45 degree fundus photograph.
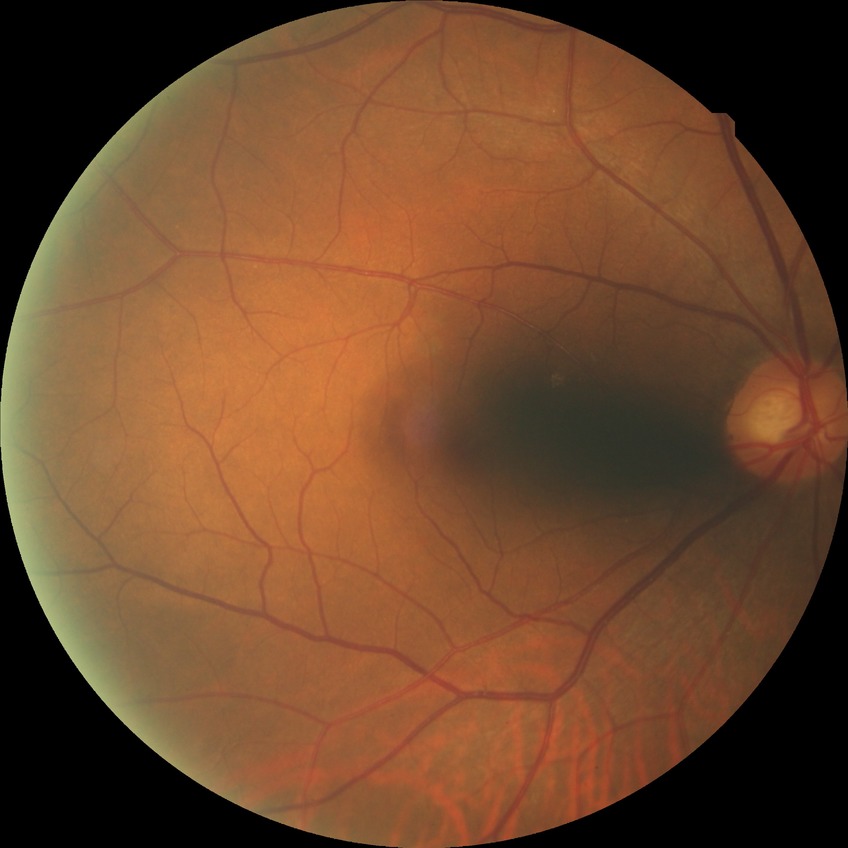 - diabetic retinopathy stage: no diabetic retinopathy